No pharmacologic dilation
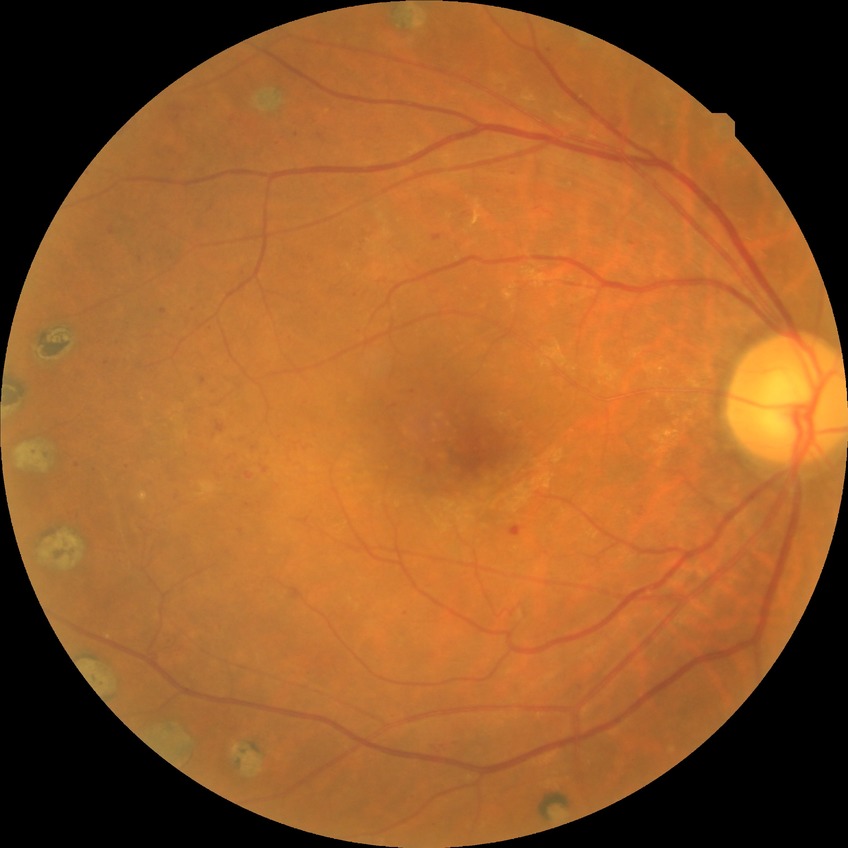
Modified Davis grade: PDR.